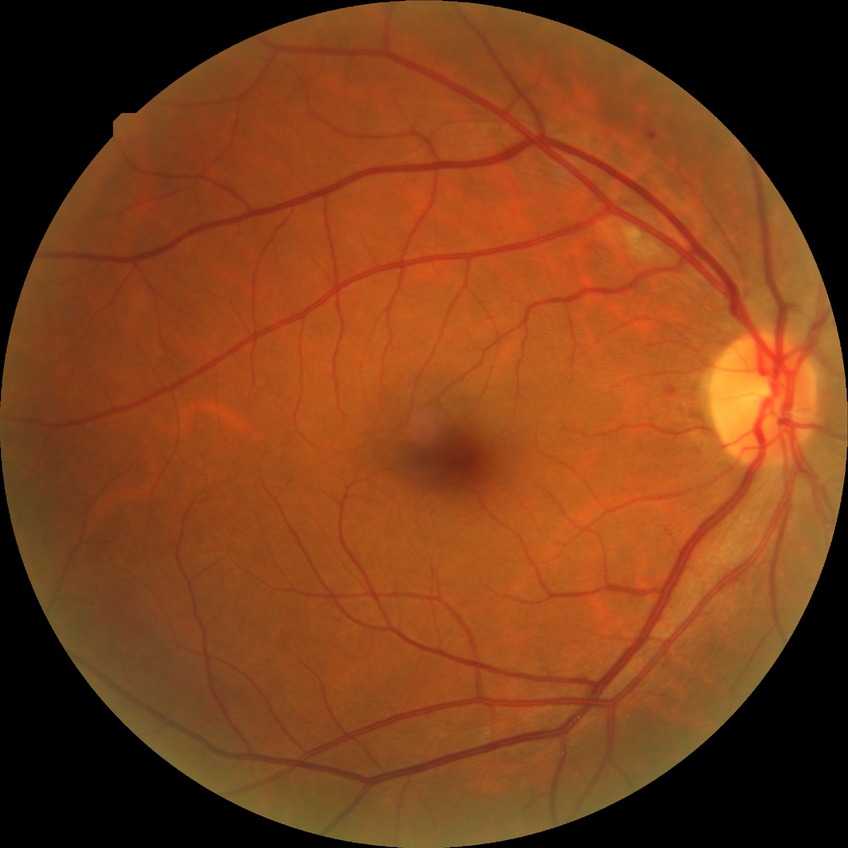
modified Davis grade: SDR; DR class: non-proliferative diabetic retinopathy.